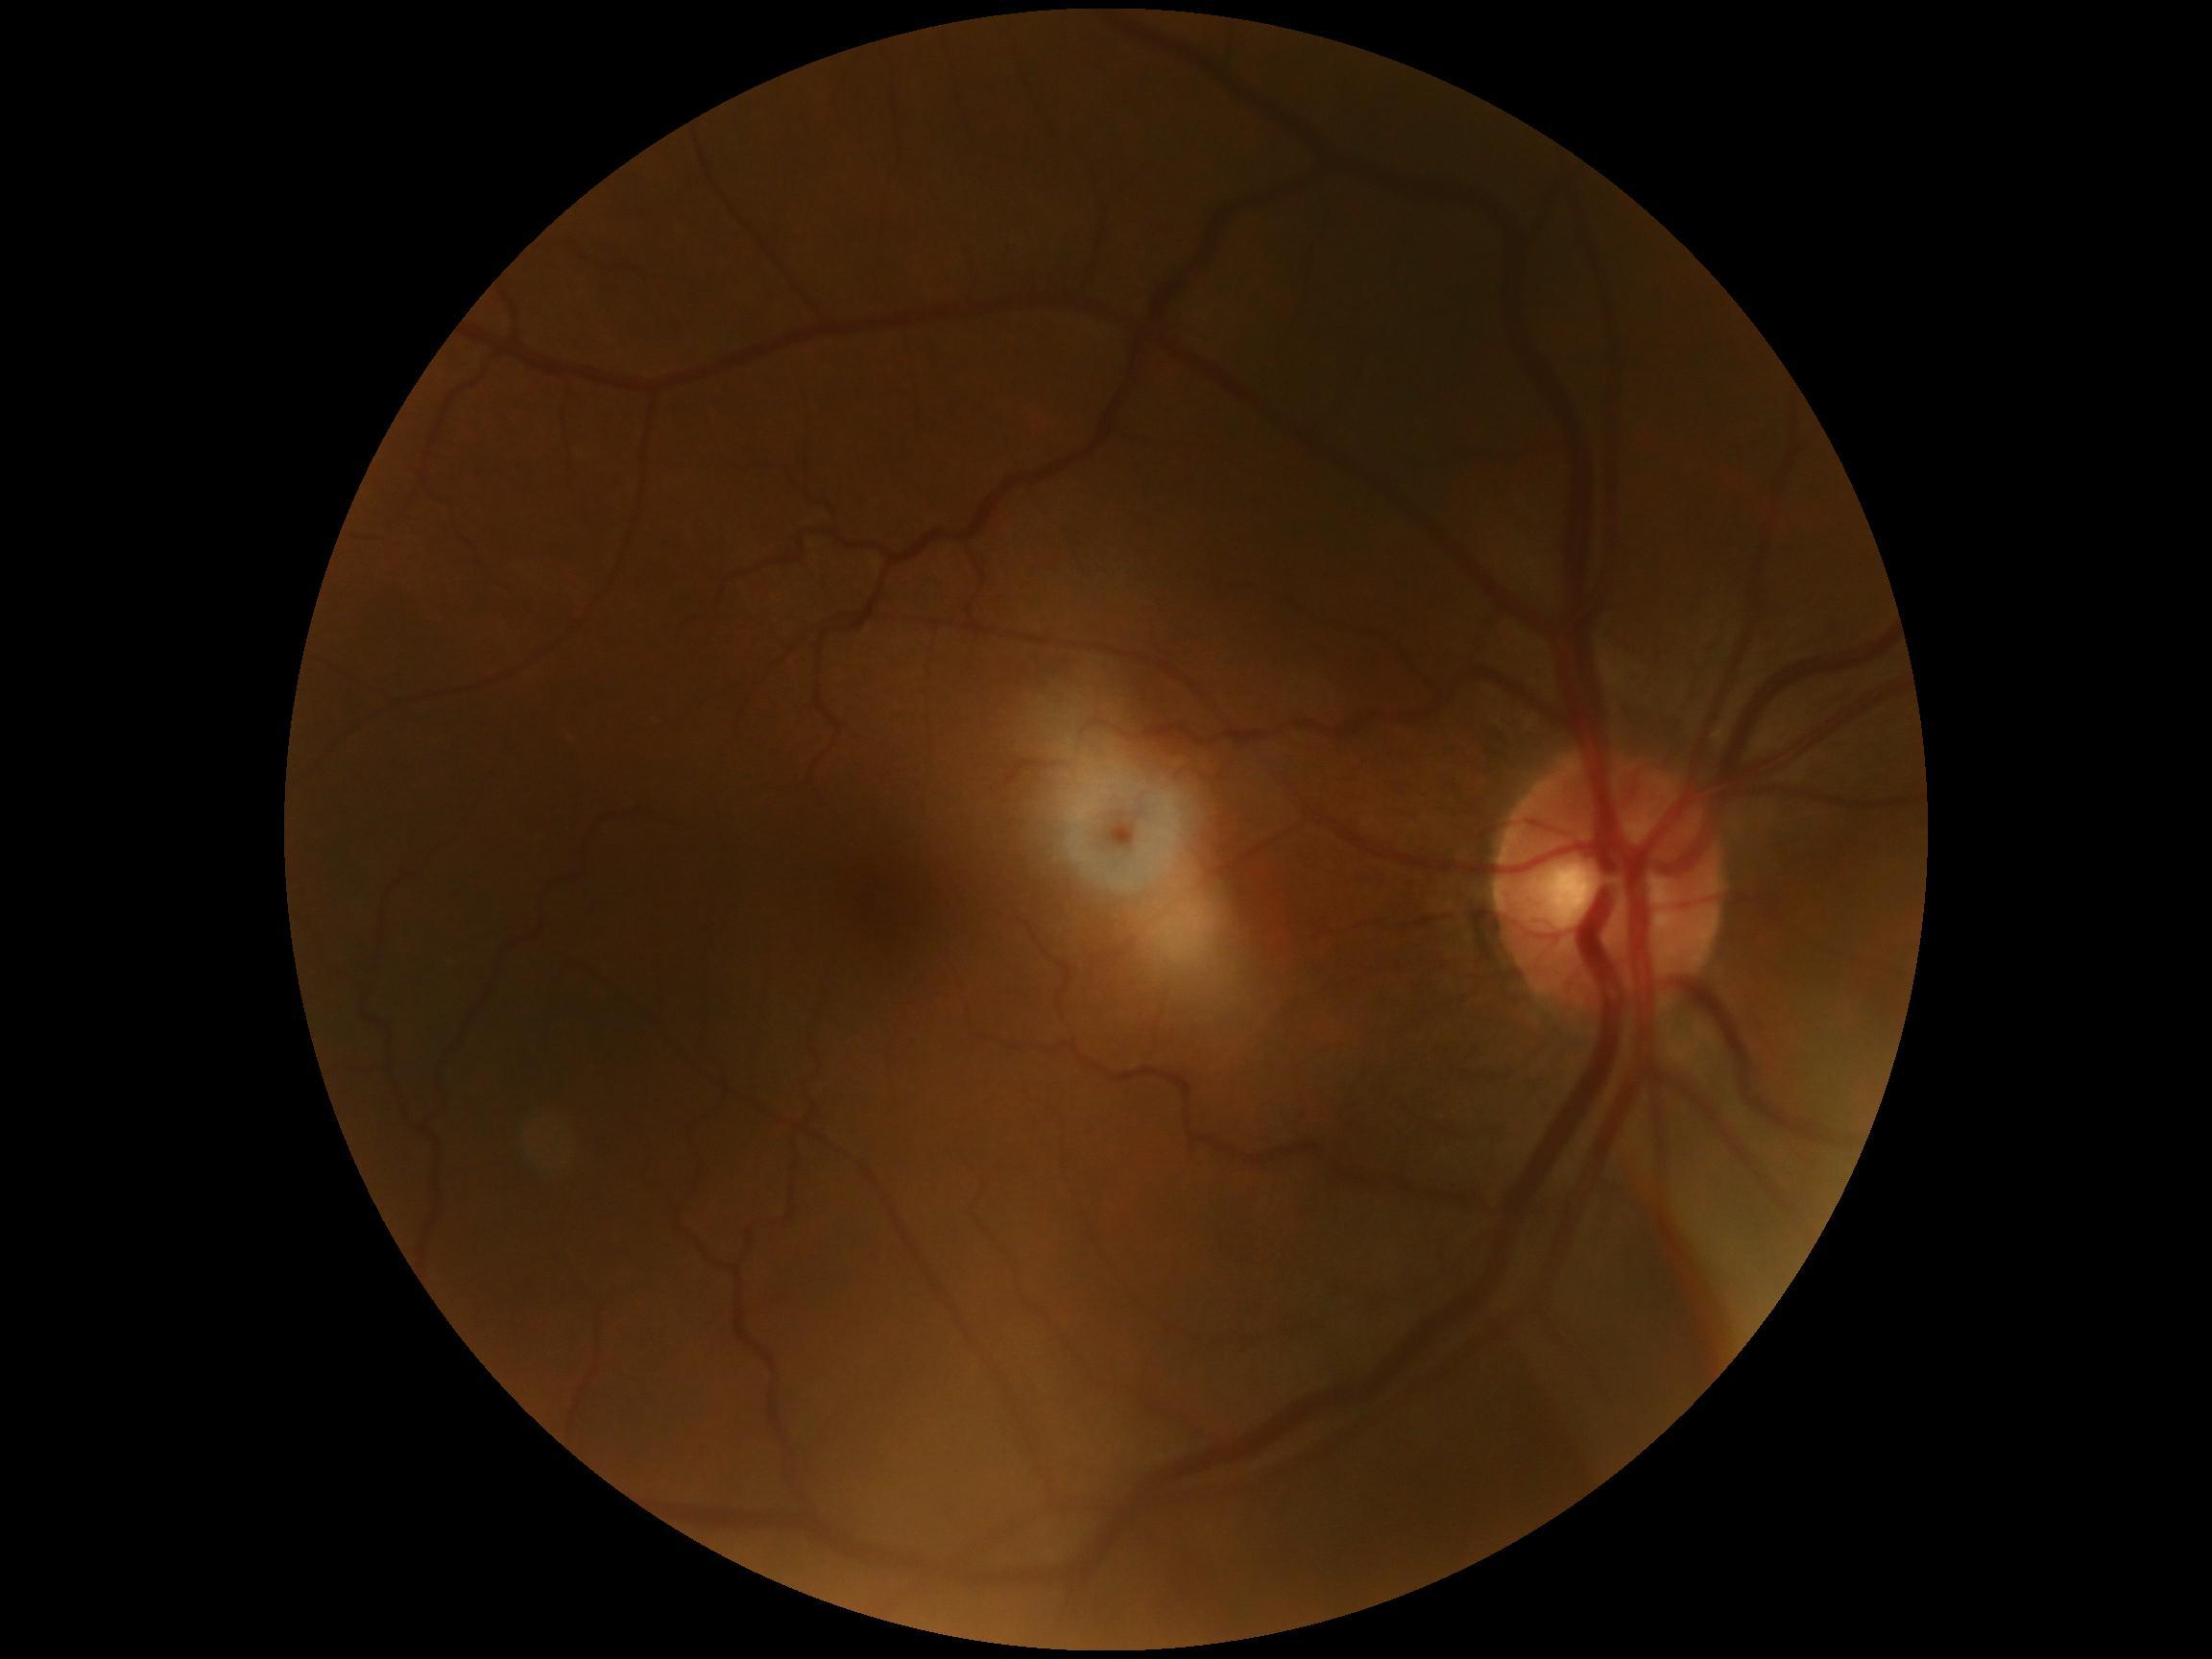
Diabetic retinopathy (DR) is no apparent diabetic retinopathy (grade 0). No signs of diabetic retinopathy.